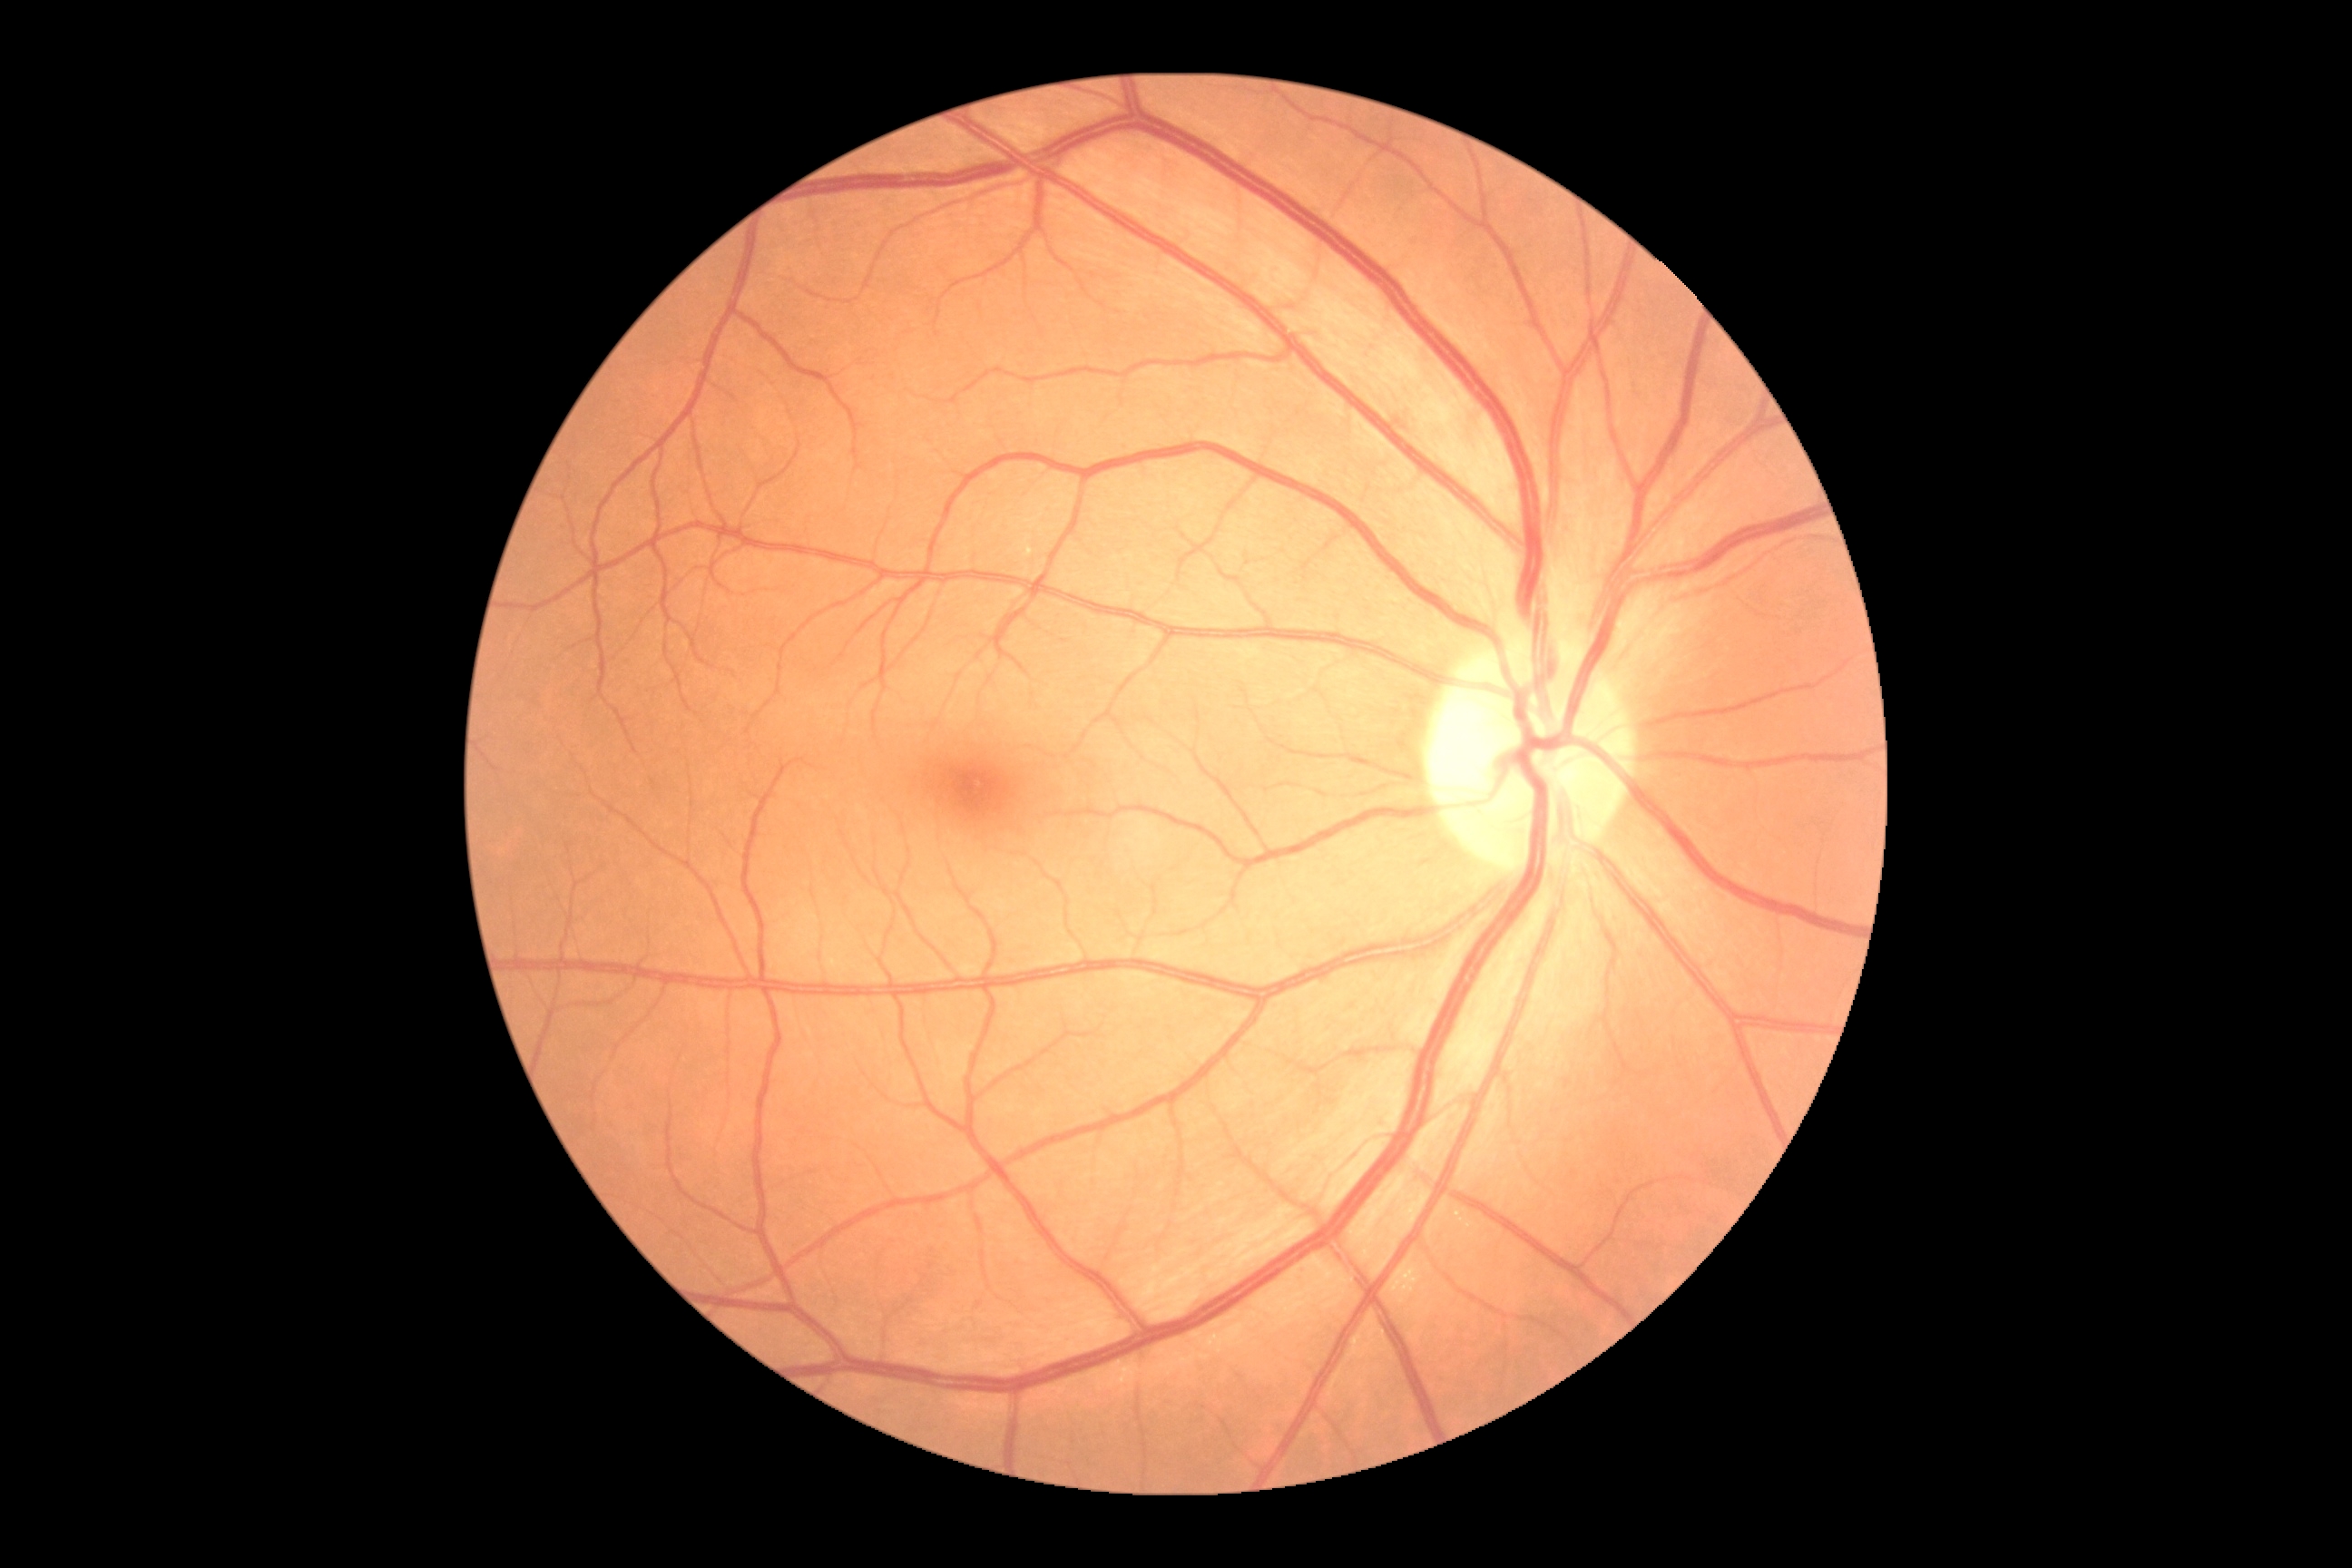 DR grade is no apparent retinopathy (0).